Image size 2352x1568
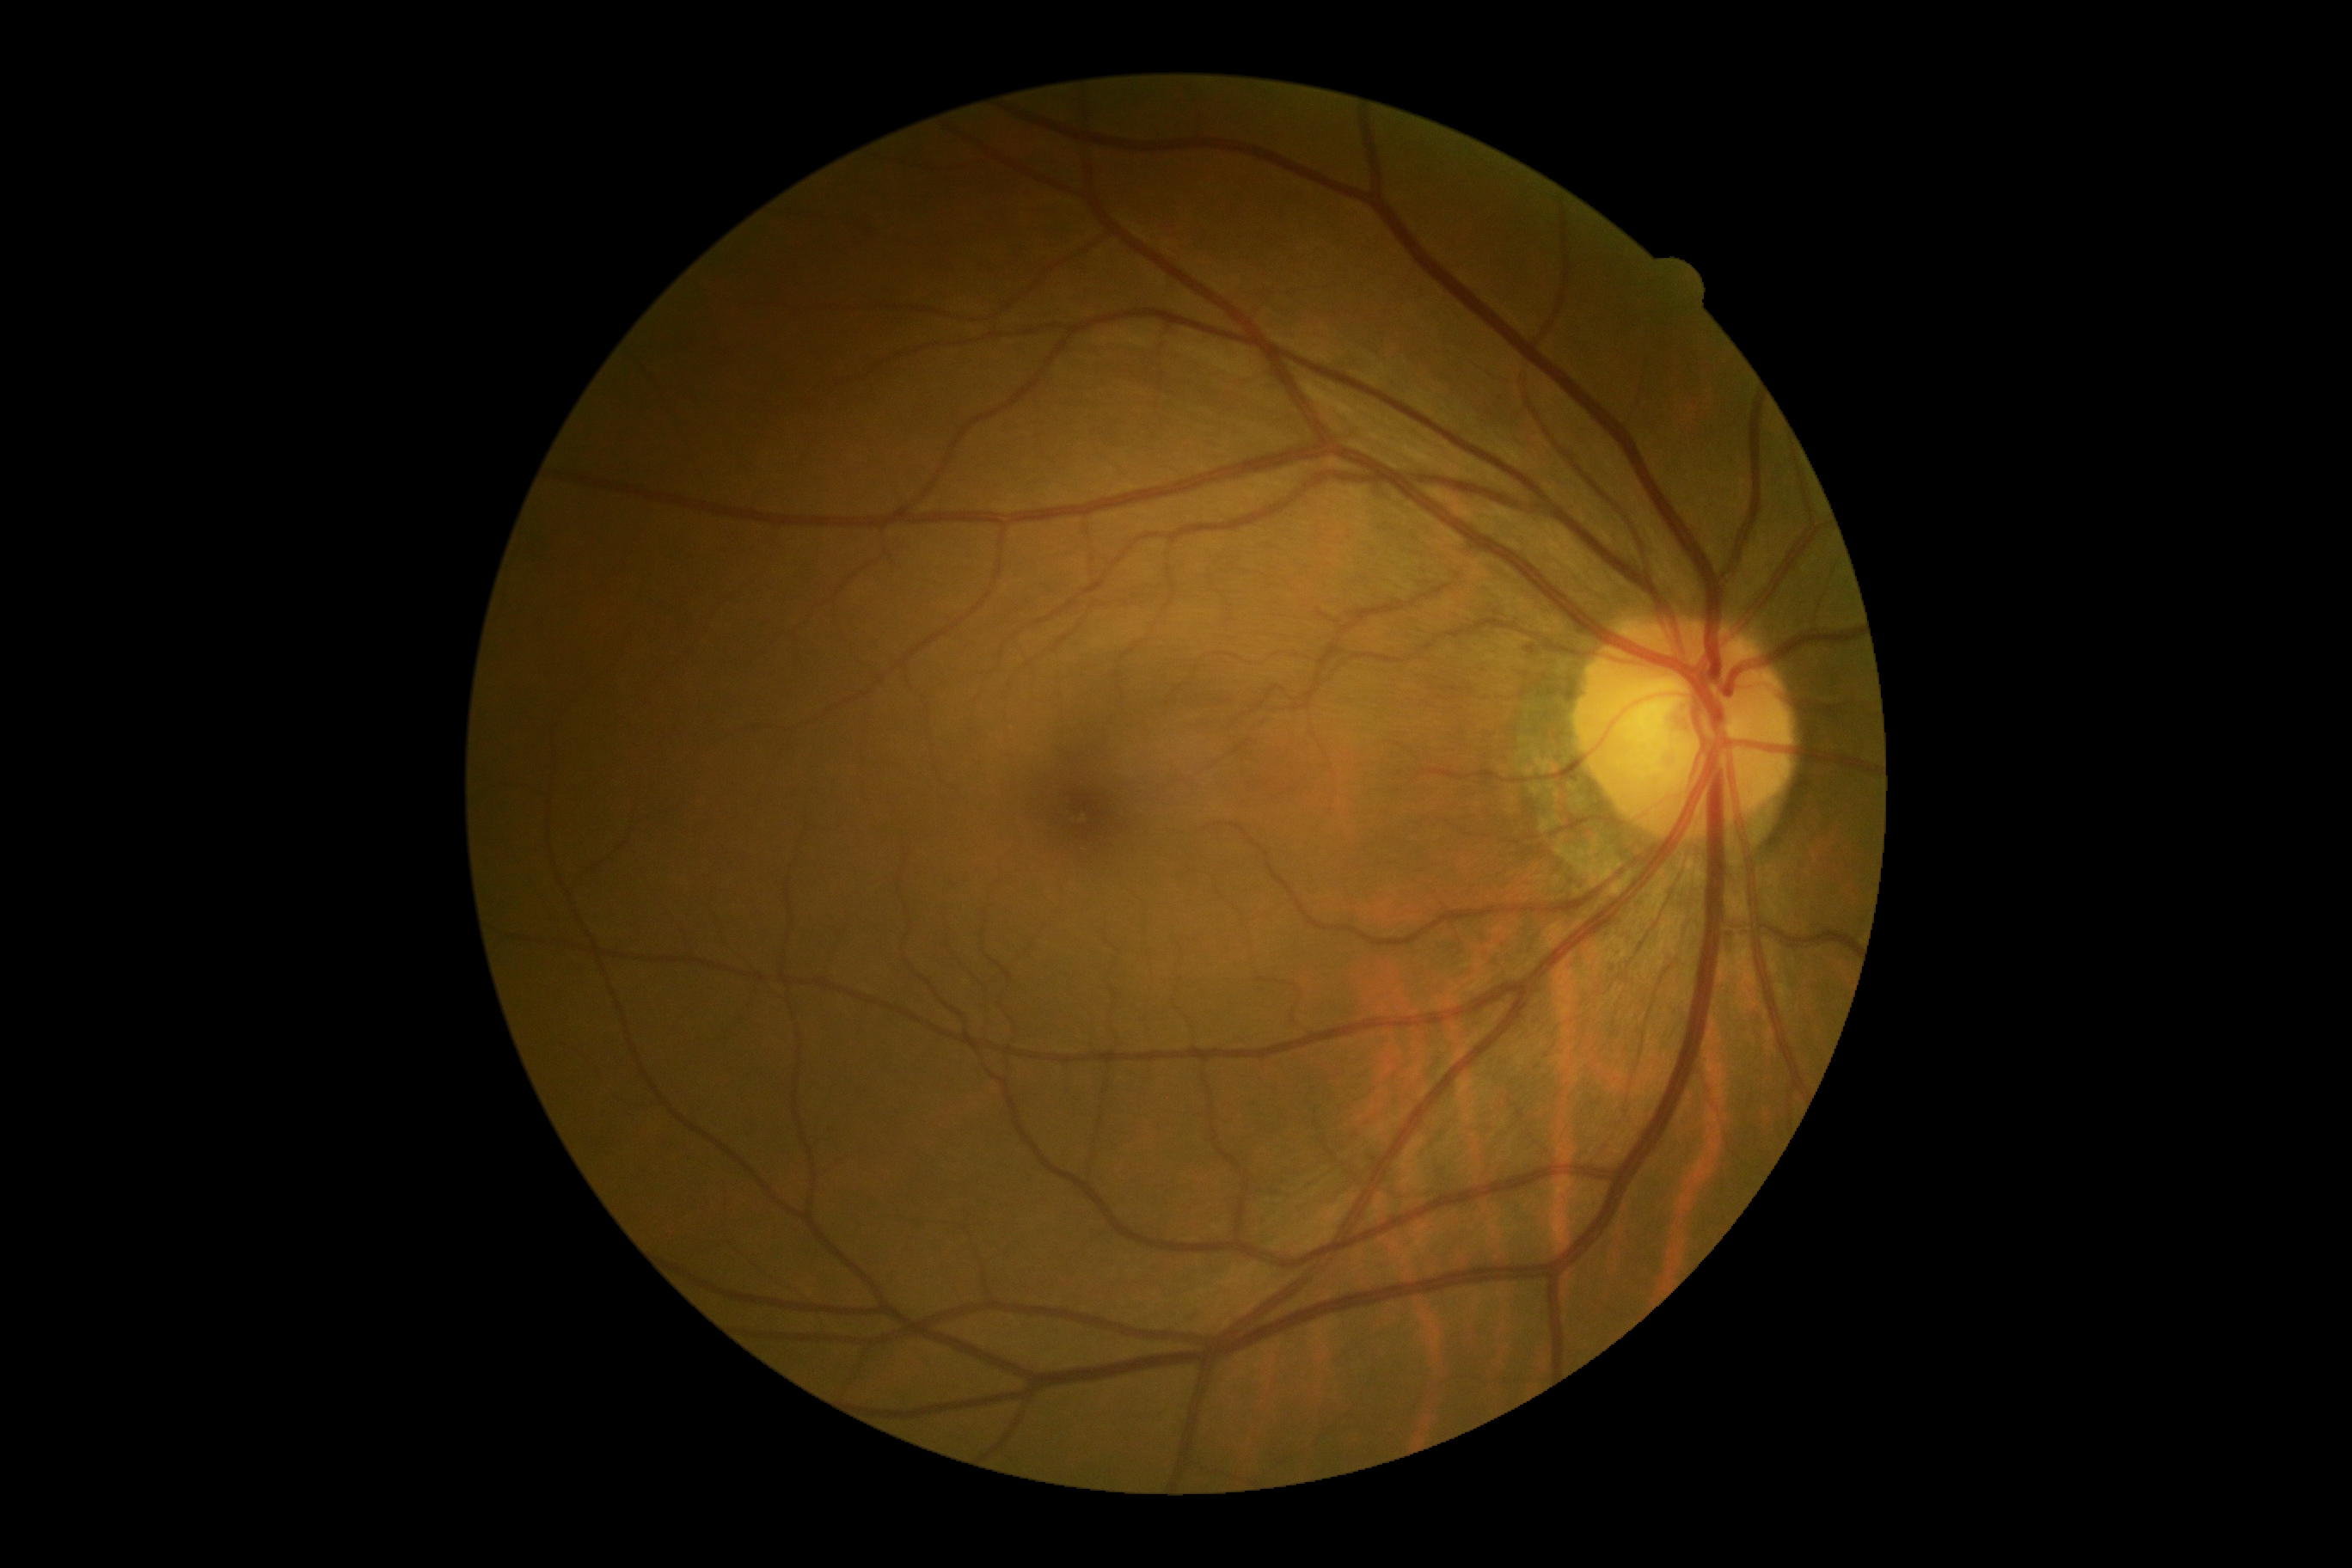 diabetic retinopathy (DR): grade 0 (no apparent retinopathy) — no visible signs of diabetic retinopathy.